Camera: Topcon TRC-NW400 · age 50 · 2212 by 1661 pixels · CFP:
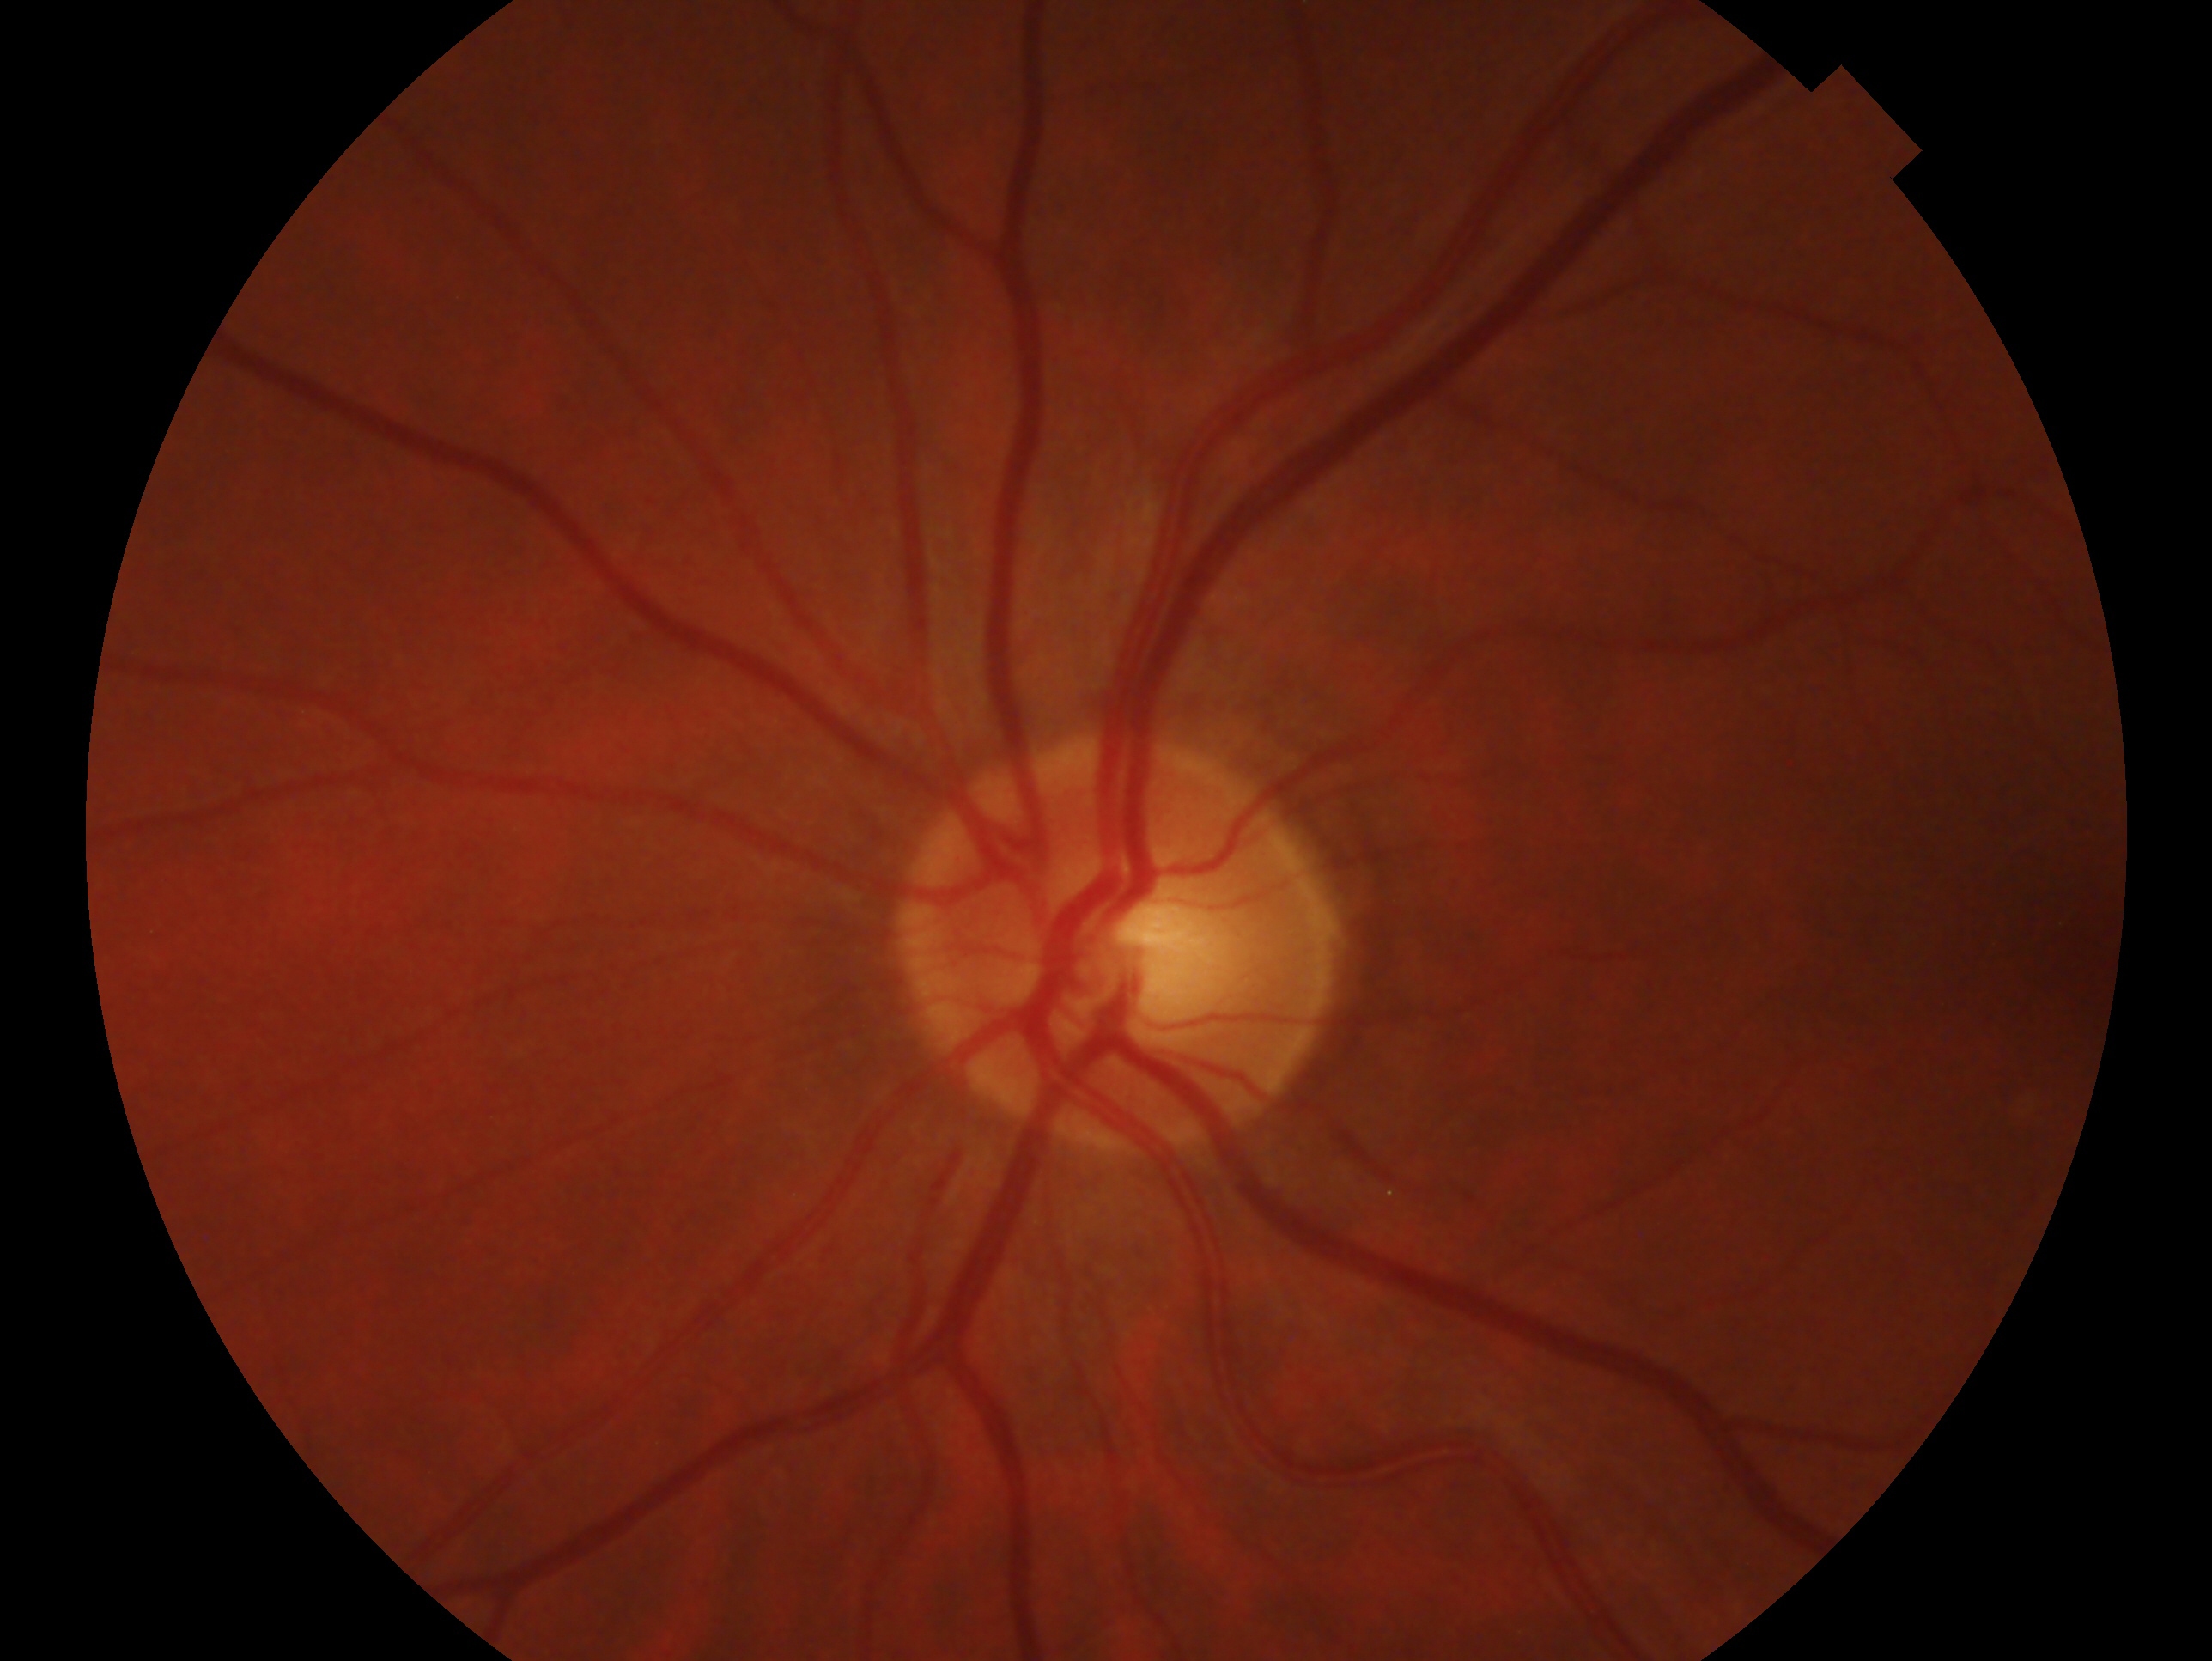 Findings:
– laterality · oculus sinister
– glaucoma status · suspected glaucoma